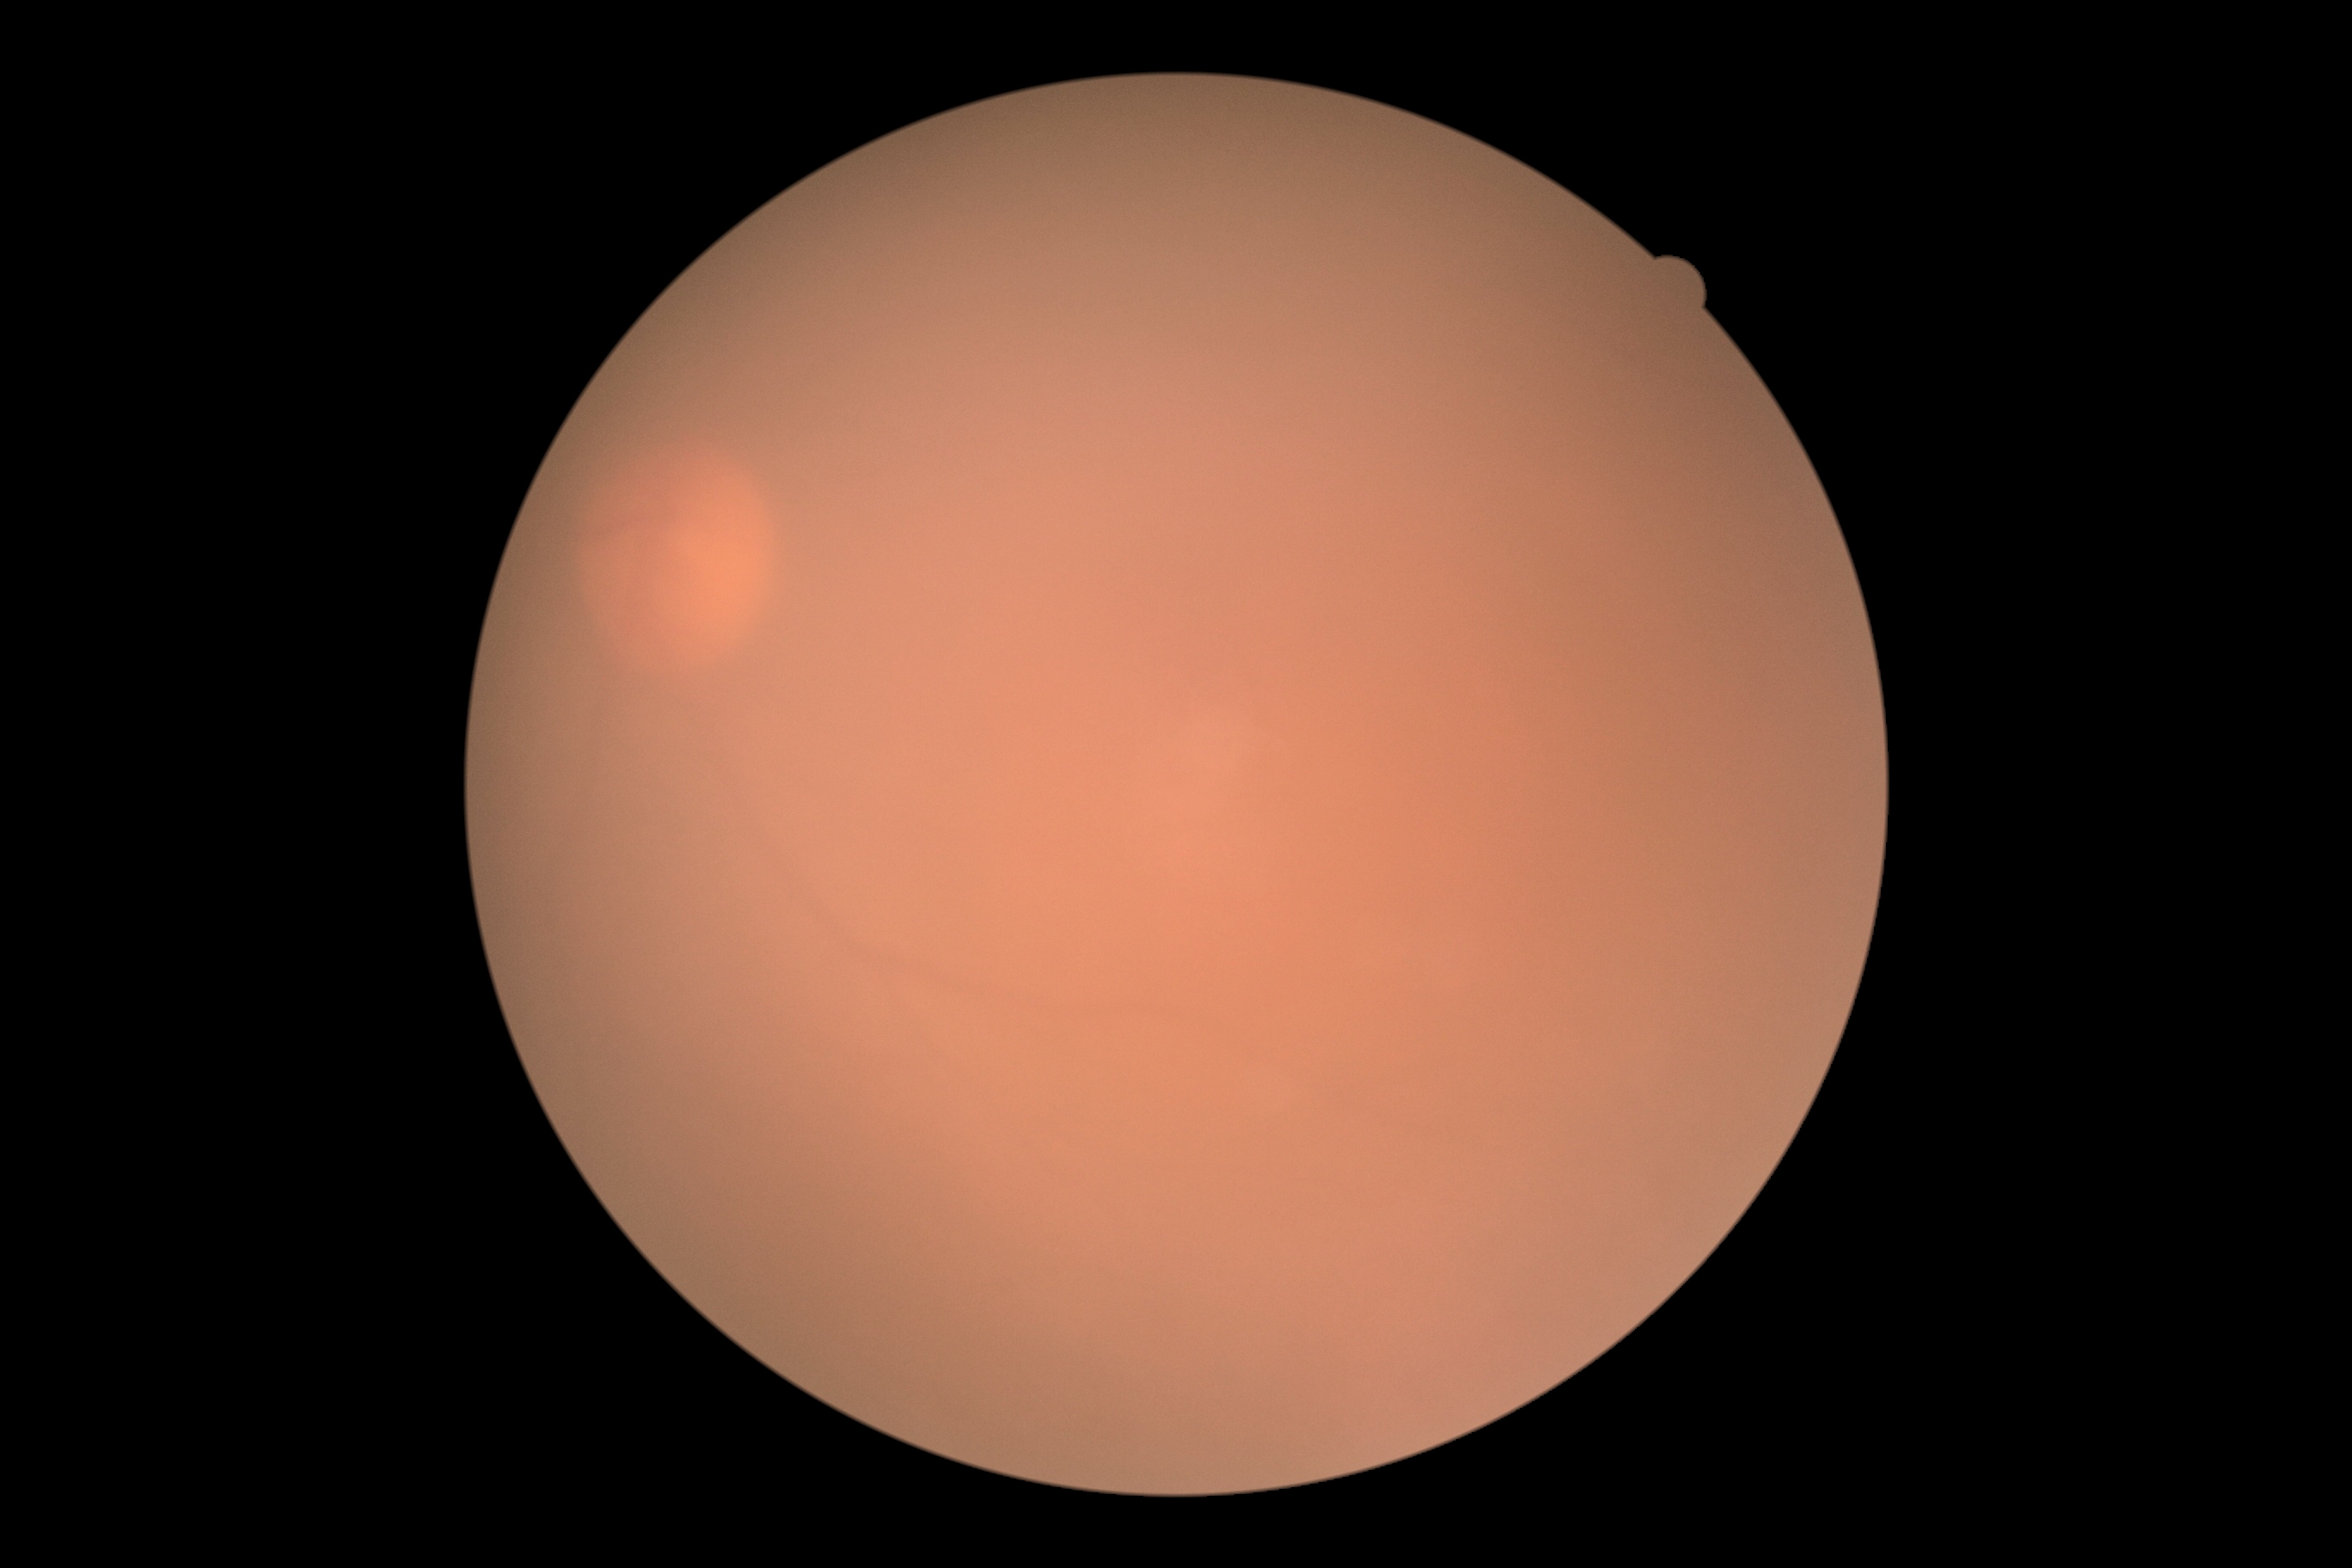

Retinopathy is ungradable due to poor image quality.
Quality too poor to assess for DR.